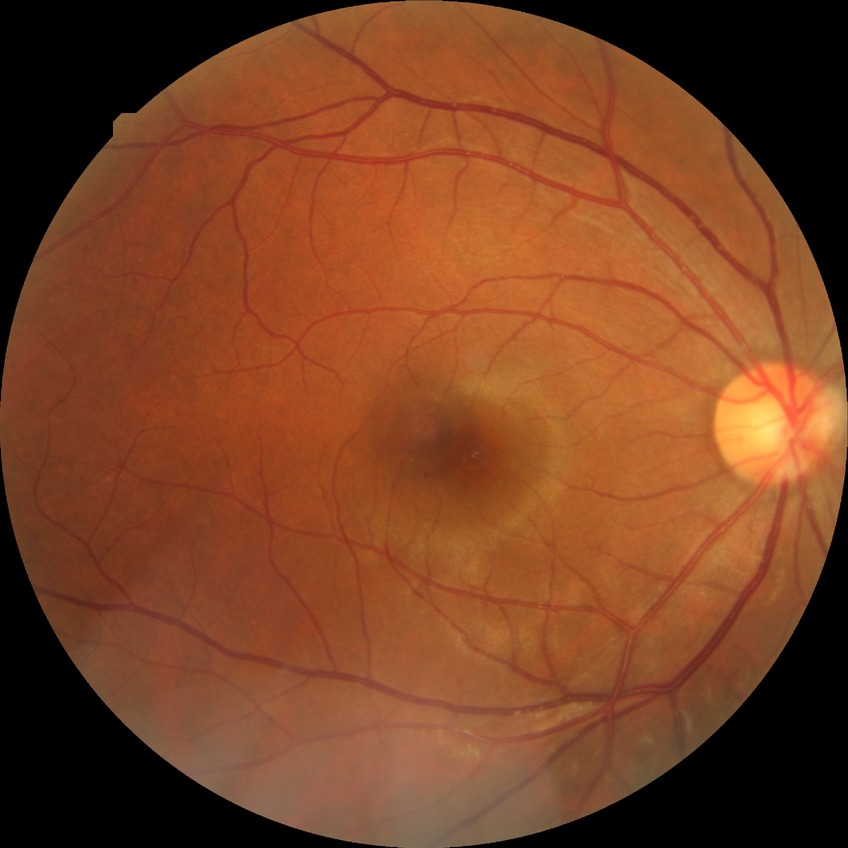

Diabetic retinopathy (DR) is simple diabetic retinopathy (SDR).